CFP:
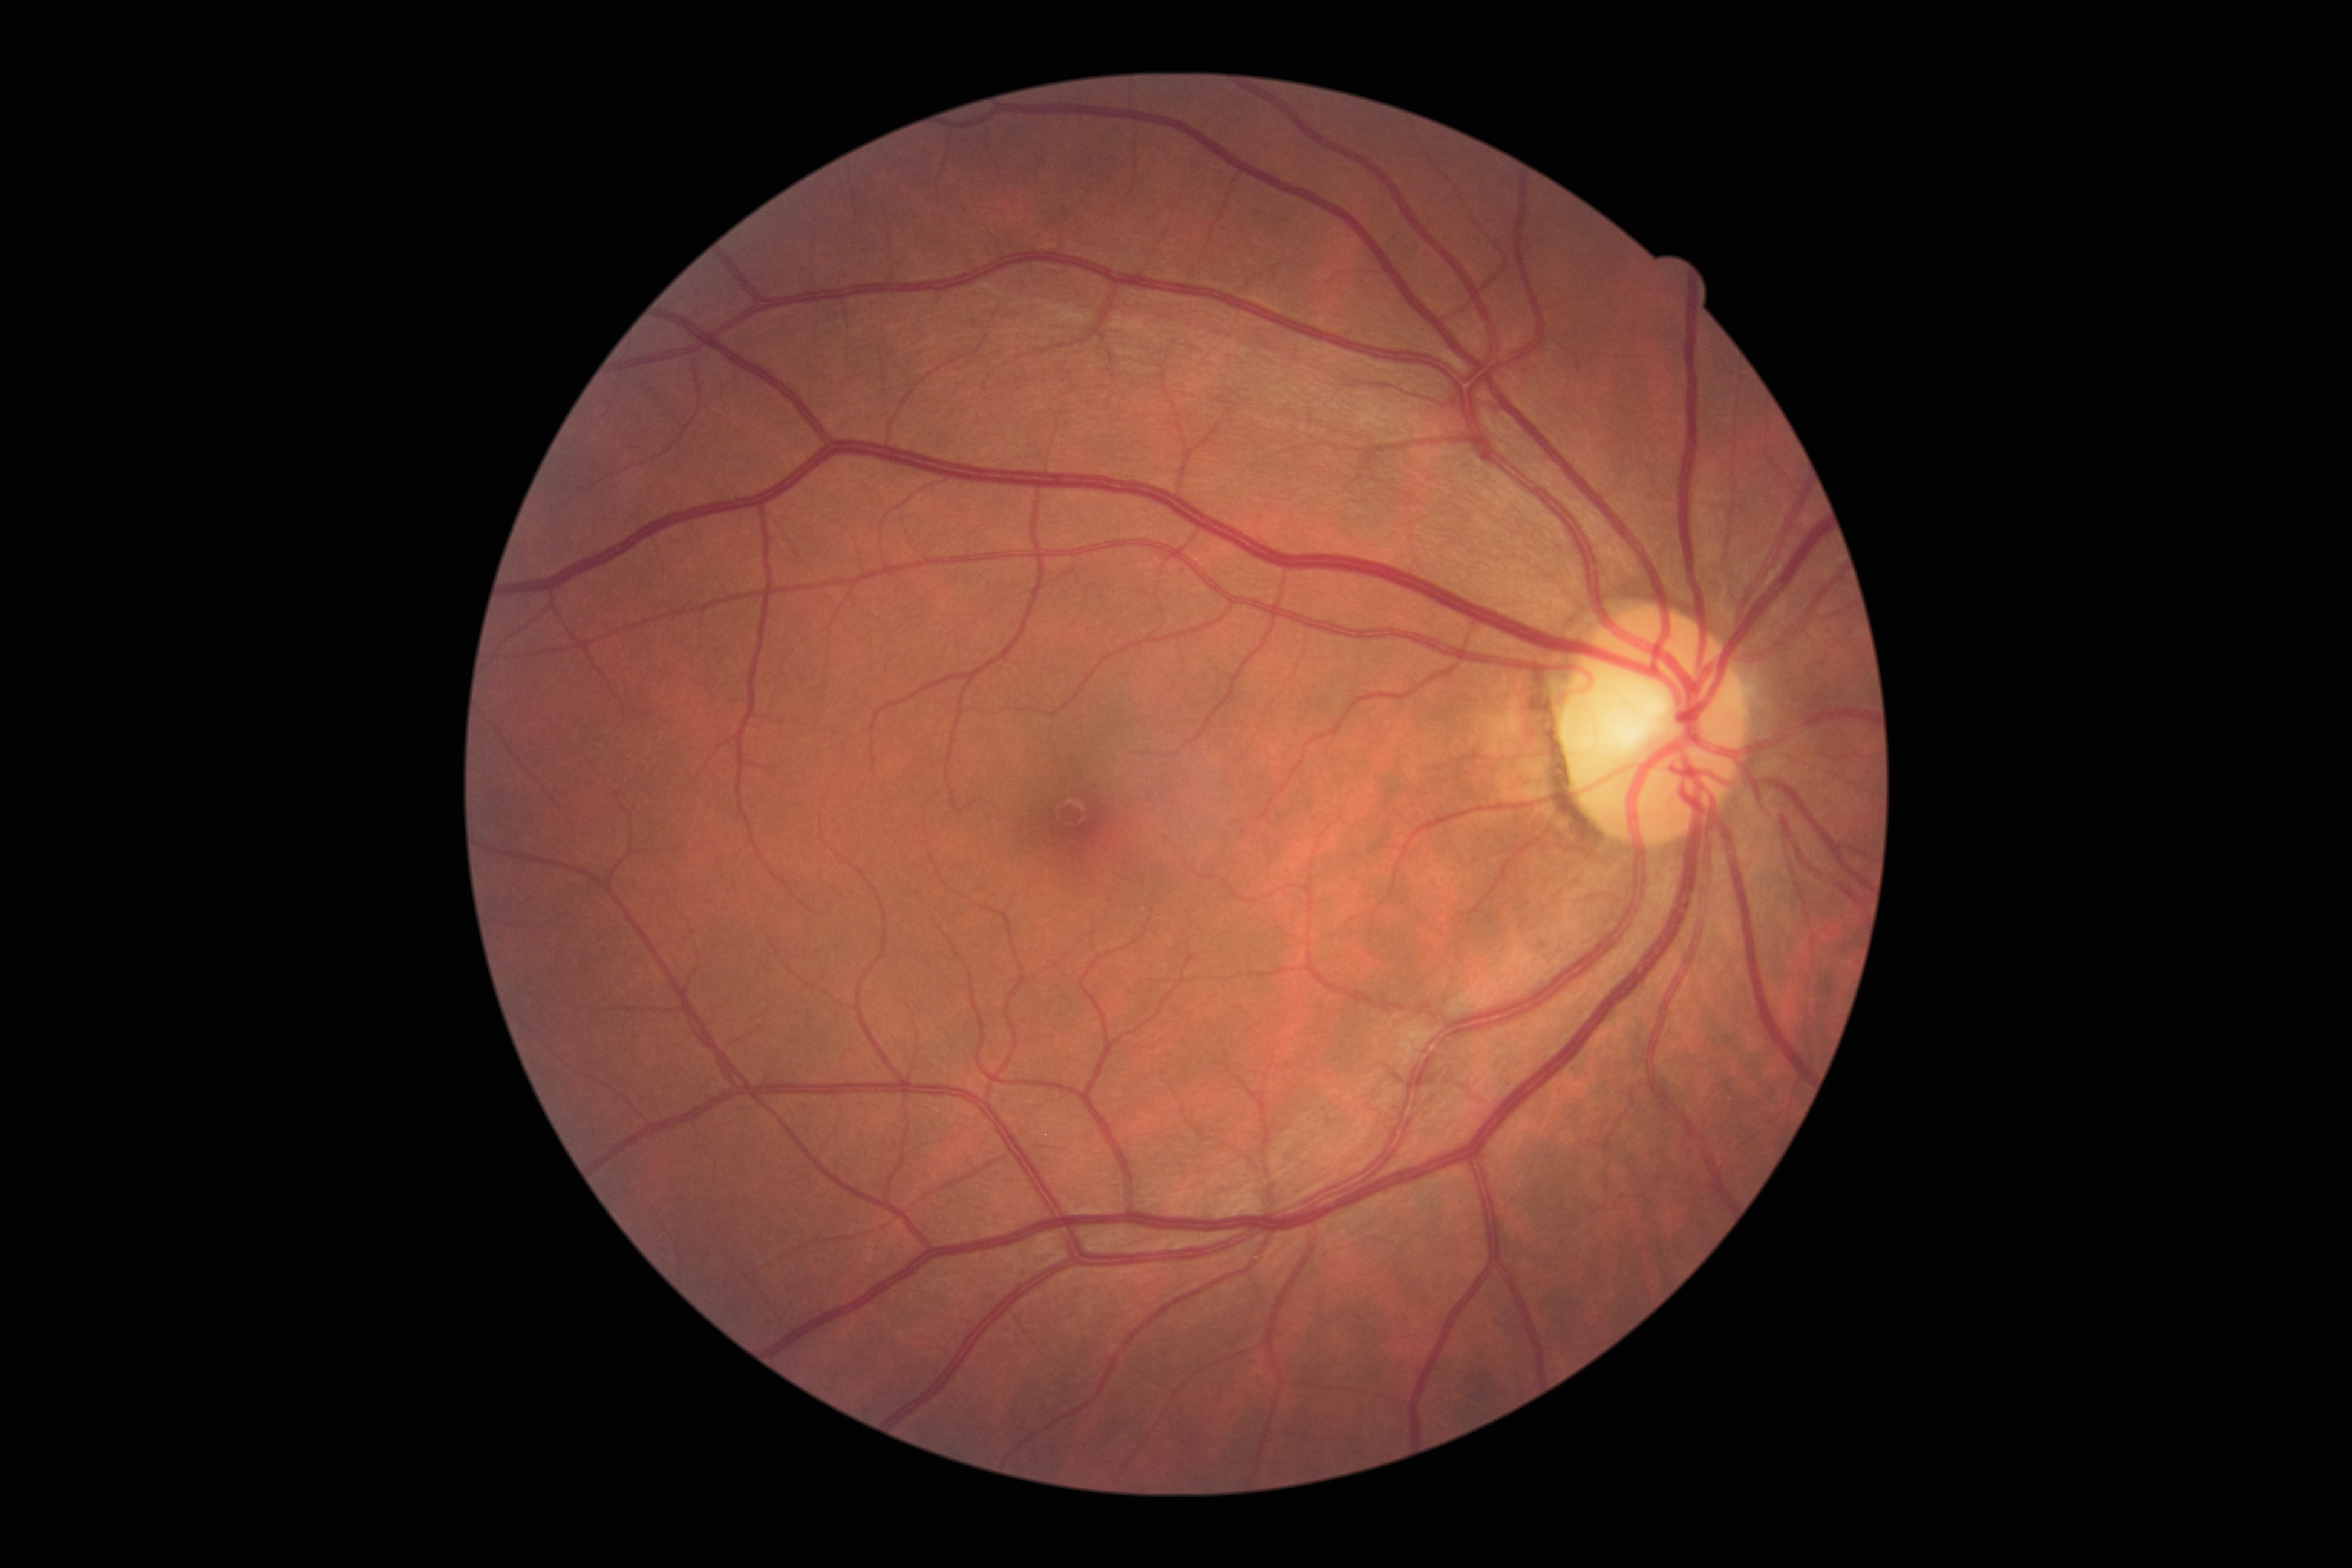 DR severity@grade 0 (no apparent retinopathy) — no visible signs of diabetic retinopathy, DR impression@no DR findings.